Diabetic retinopathy graded by the modified Davis classification — 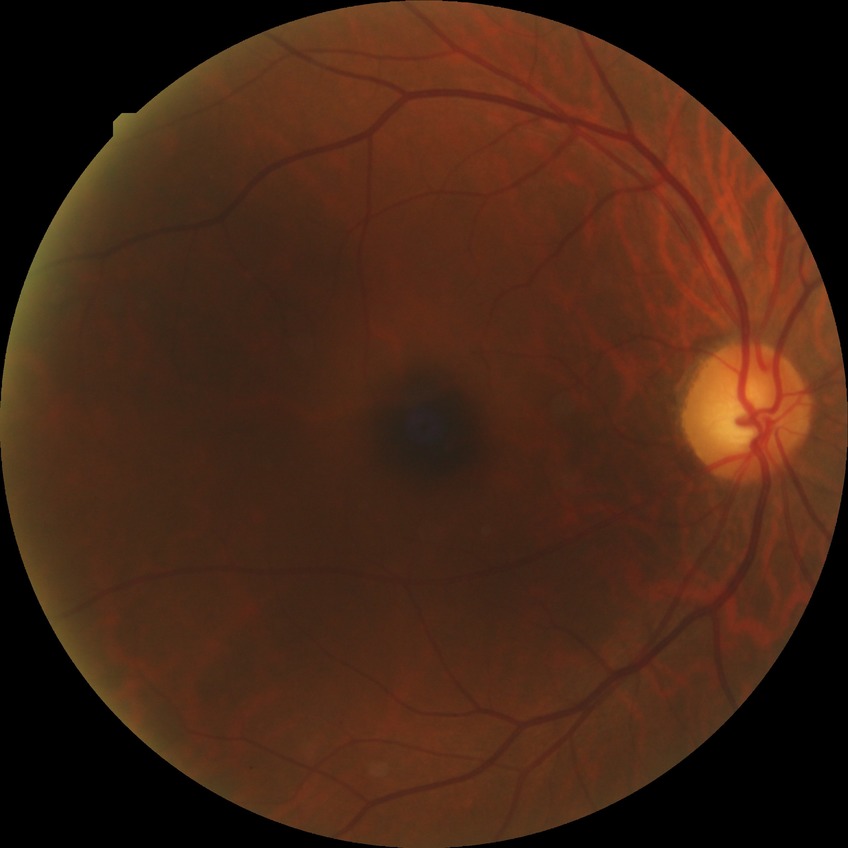
Davis grading: no diabetic retinopathy.